Modified Davis grading: 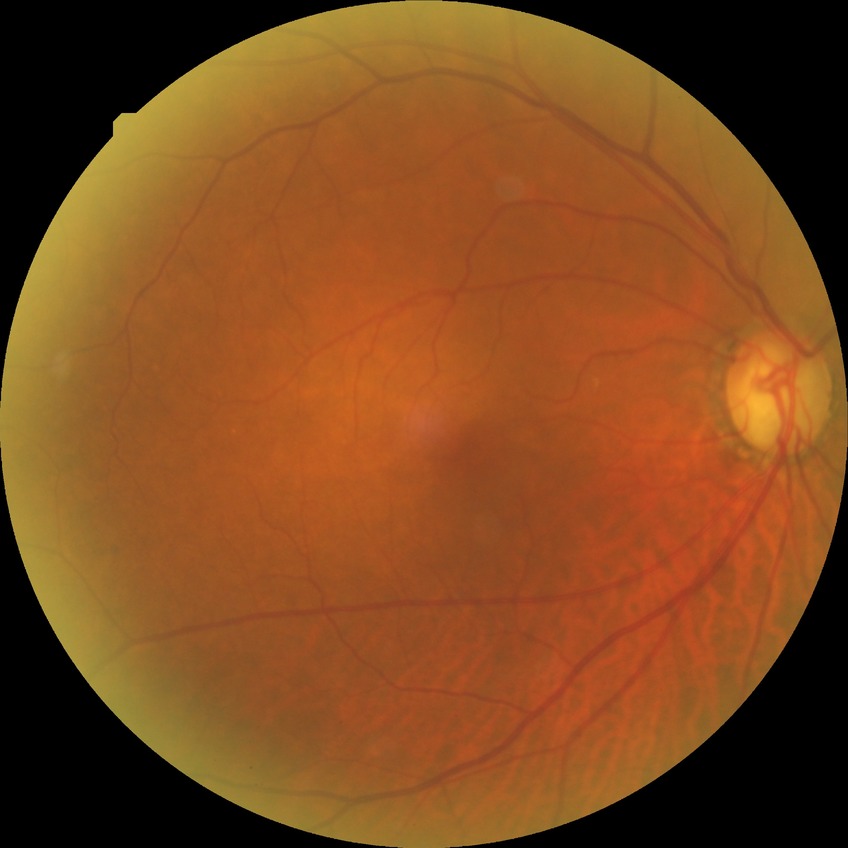
Diabetic retinopathy (DR) is no diabetic retinopathy (NDR).